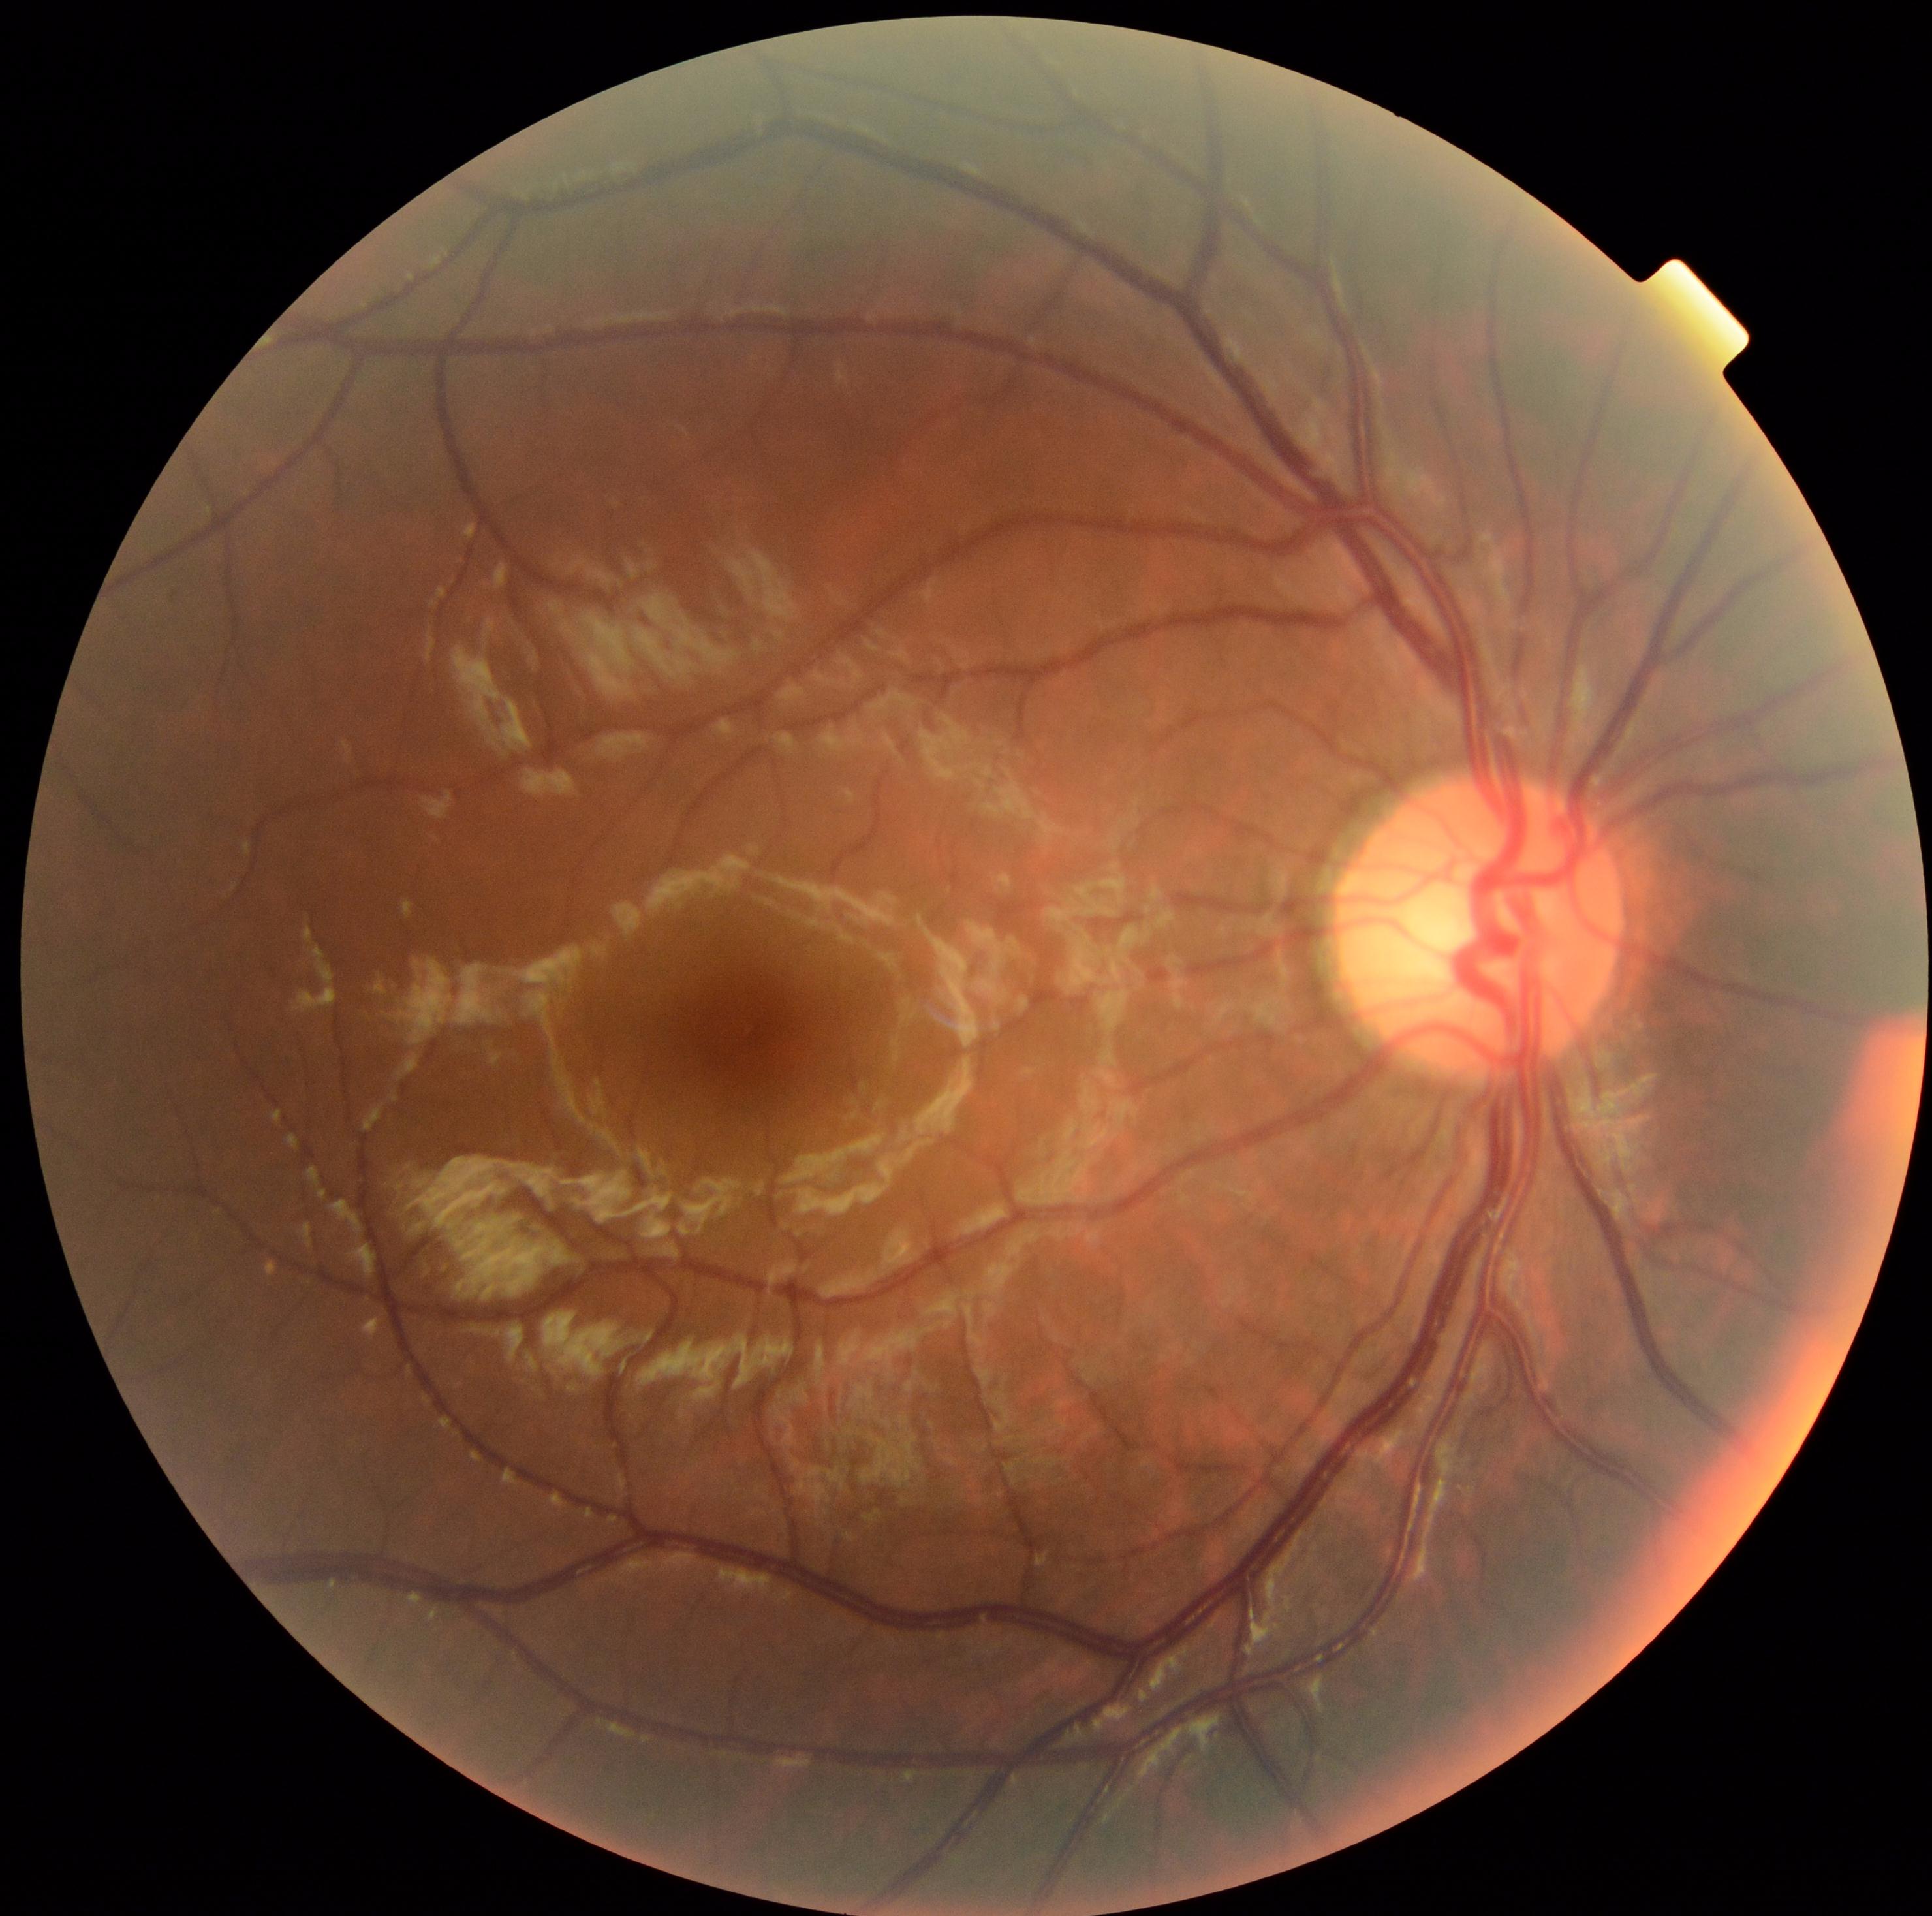

No DR findings.
Diabetic retinopathy severity: grade 0 (no apparent retinopathy).